1240x1240px · camera: Phoenix ICON (100° FOV) · infant wide-field retinal image
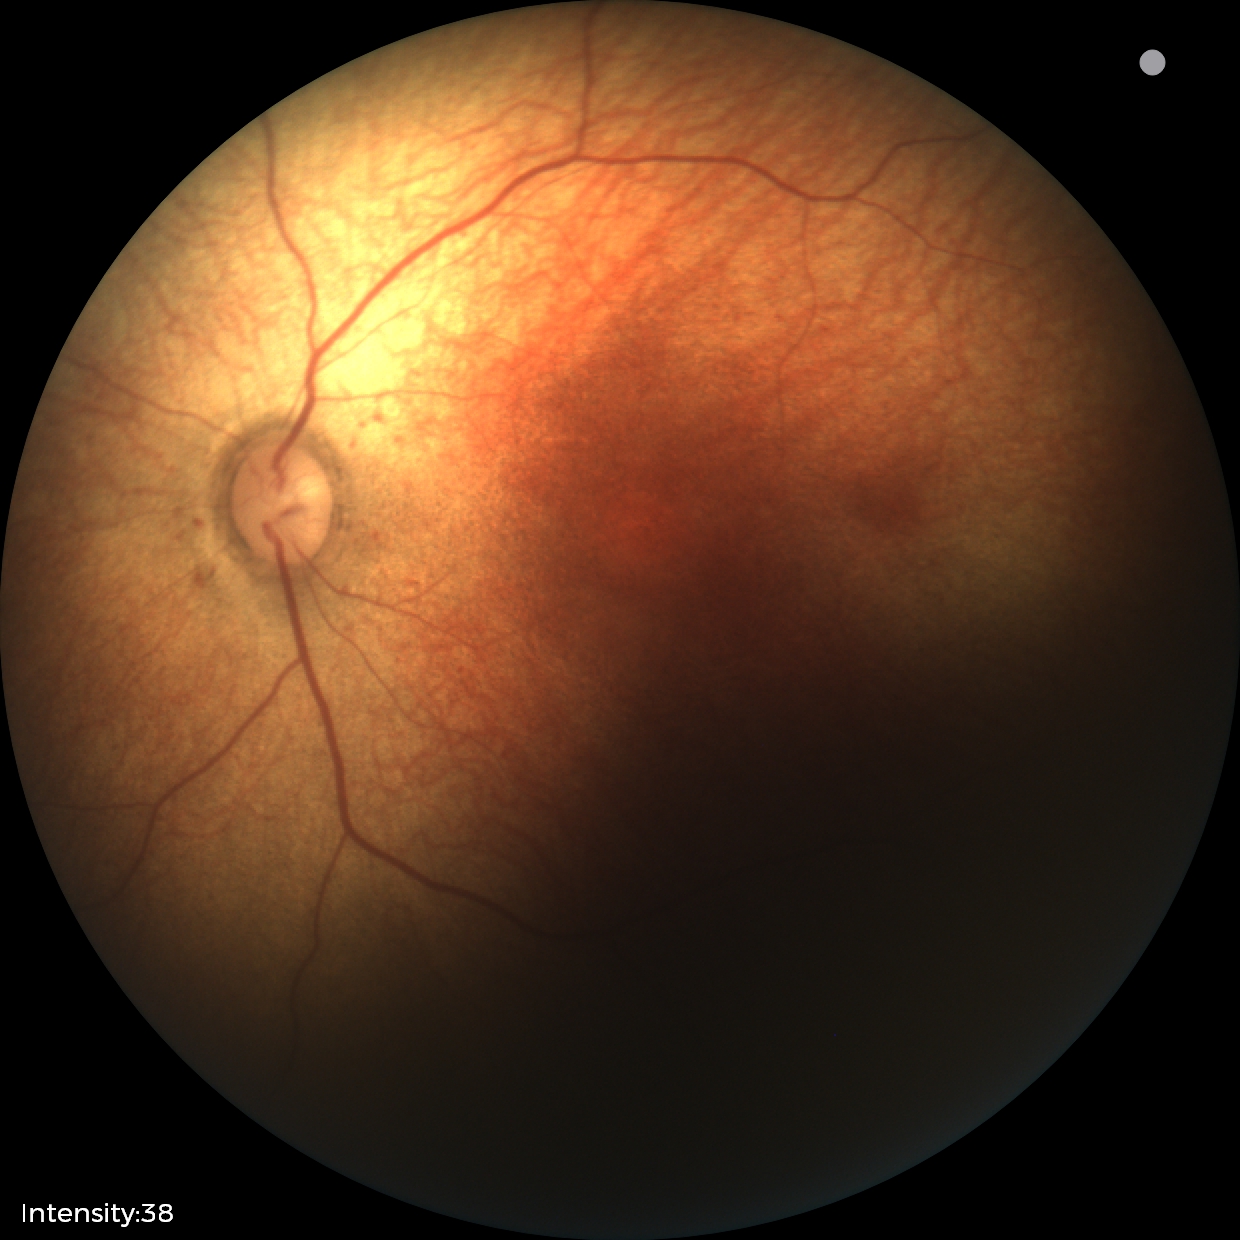

Screening diagnosis: physiological retinal finding.